RetCam wide-field infant fundus image · camera: Clarity RetCam 3 (130° FOV)
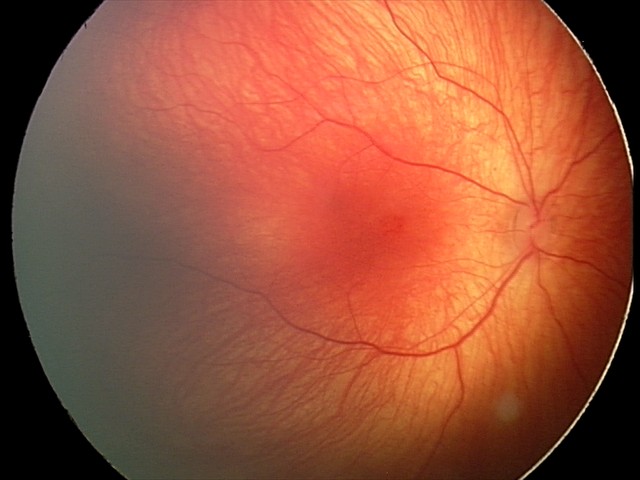

Diagnosis from this screening exam: retinal hemorrhages.